Nonmydriatic fundus photograph; modified Davis classification — 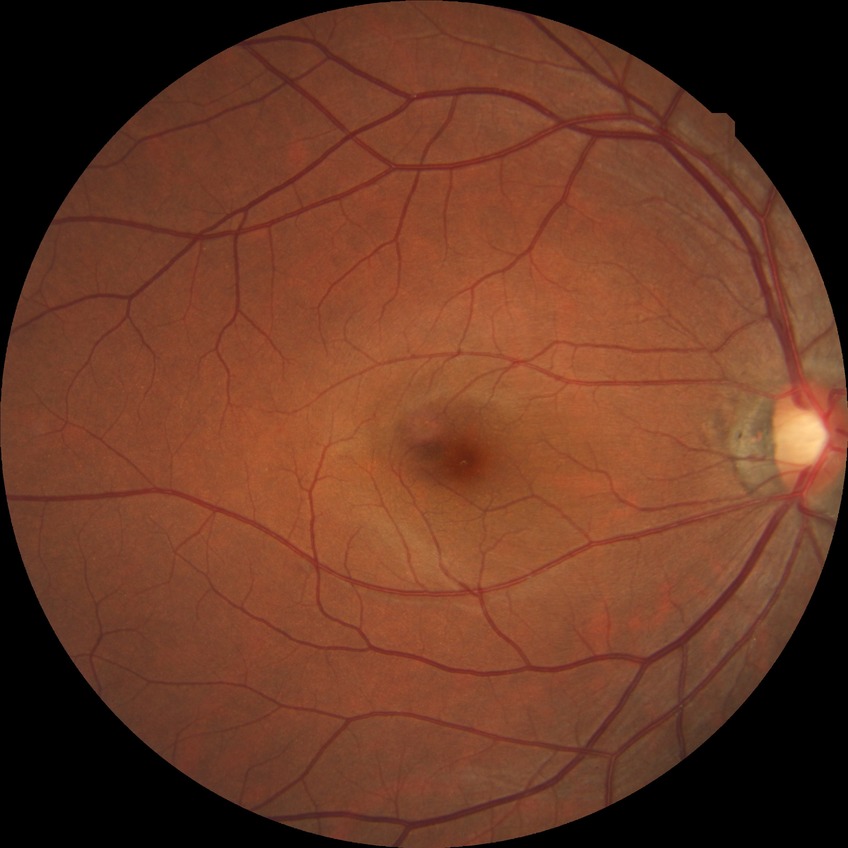 Davis DR grade is NDR.
No DR findings.